Captured after pupil dilation — 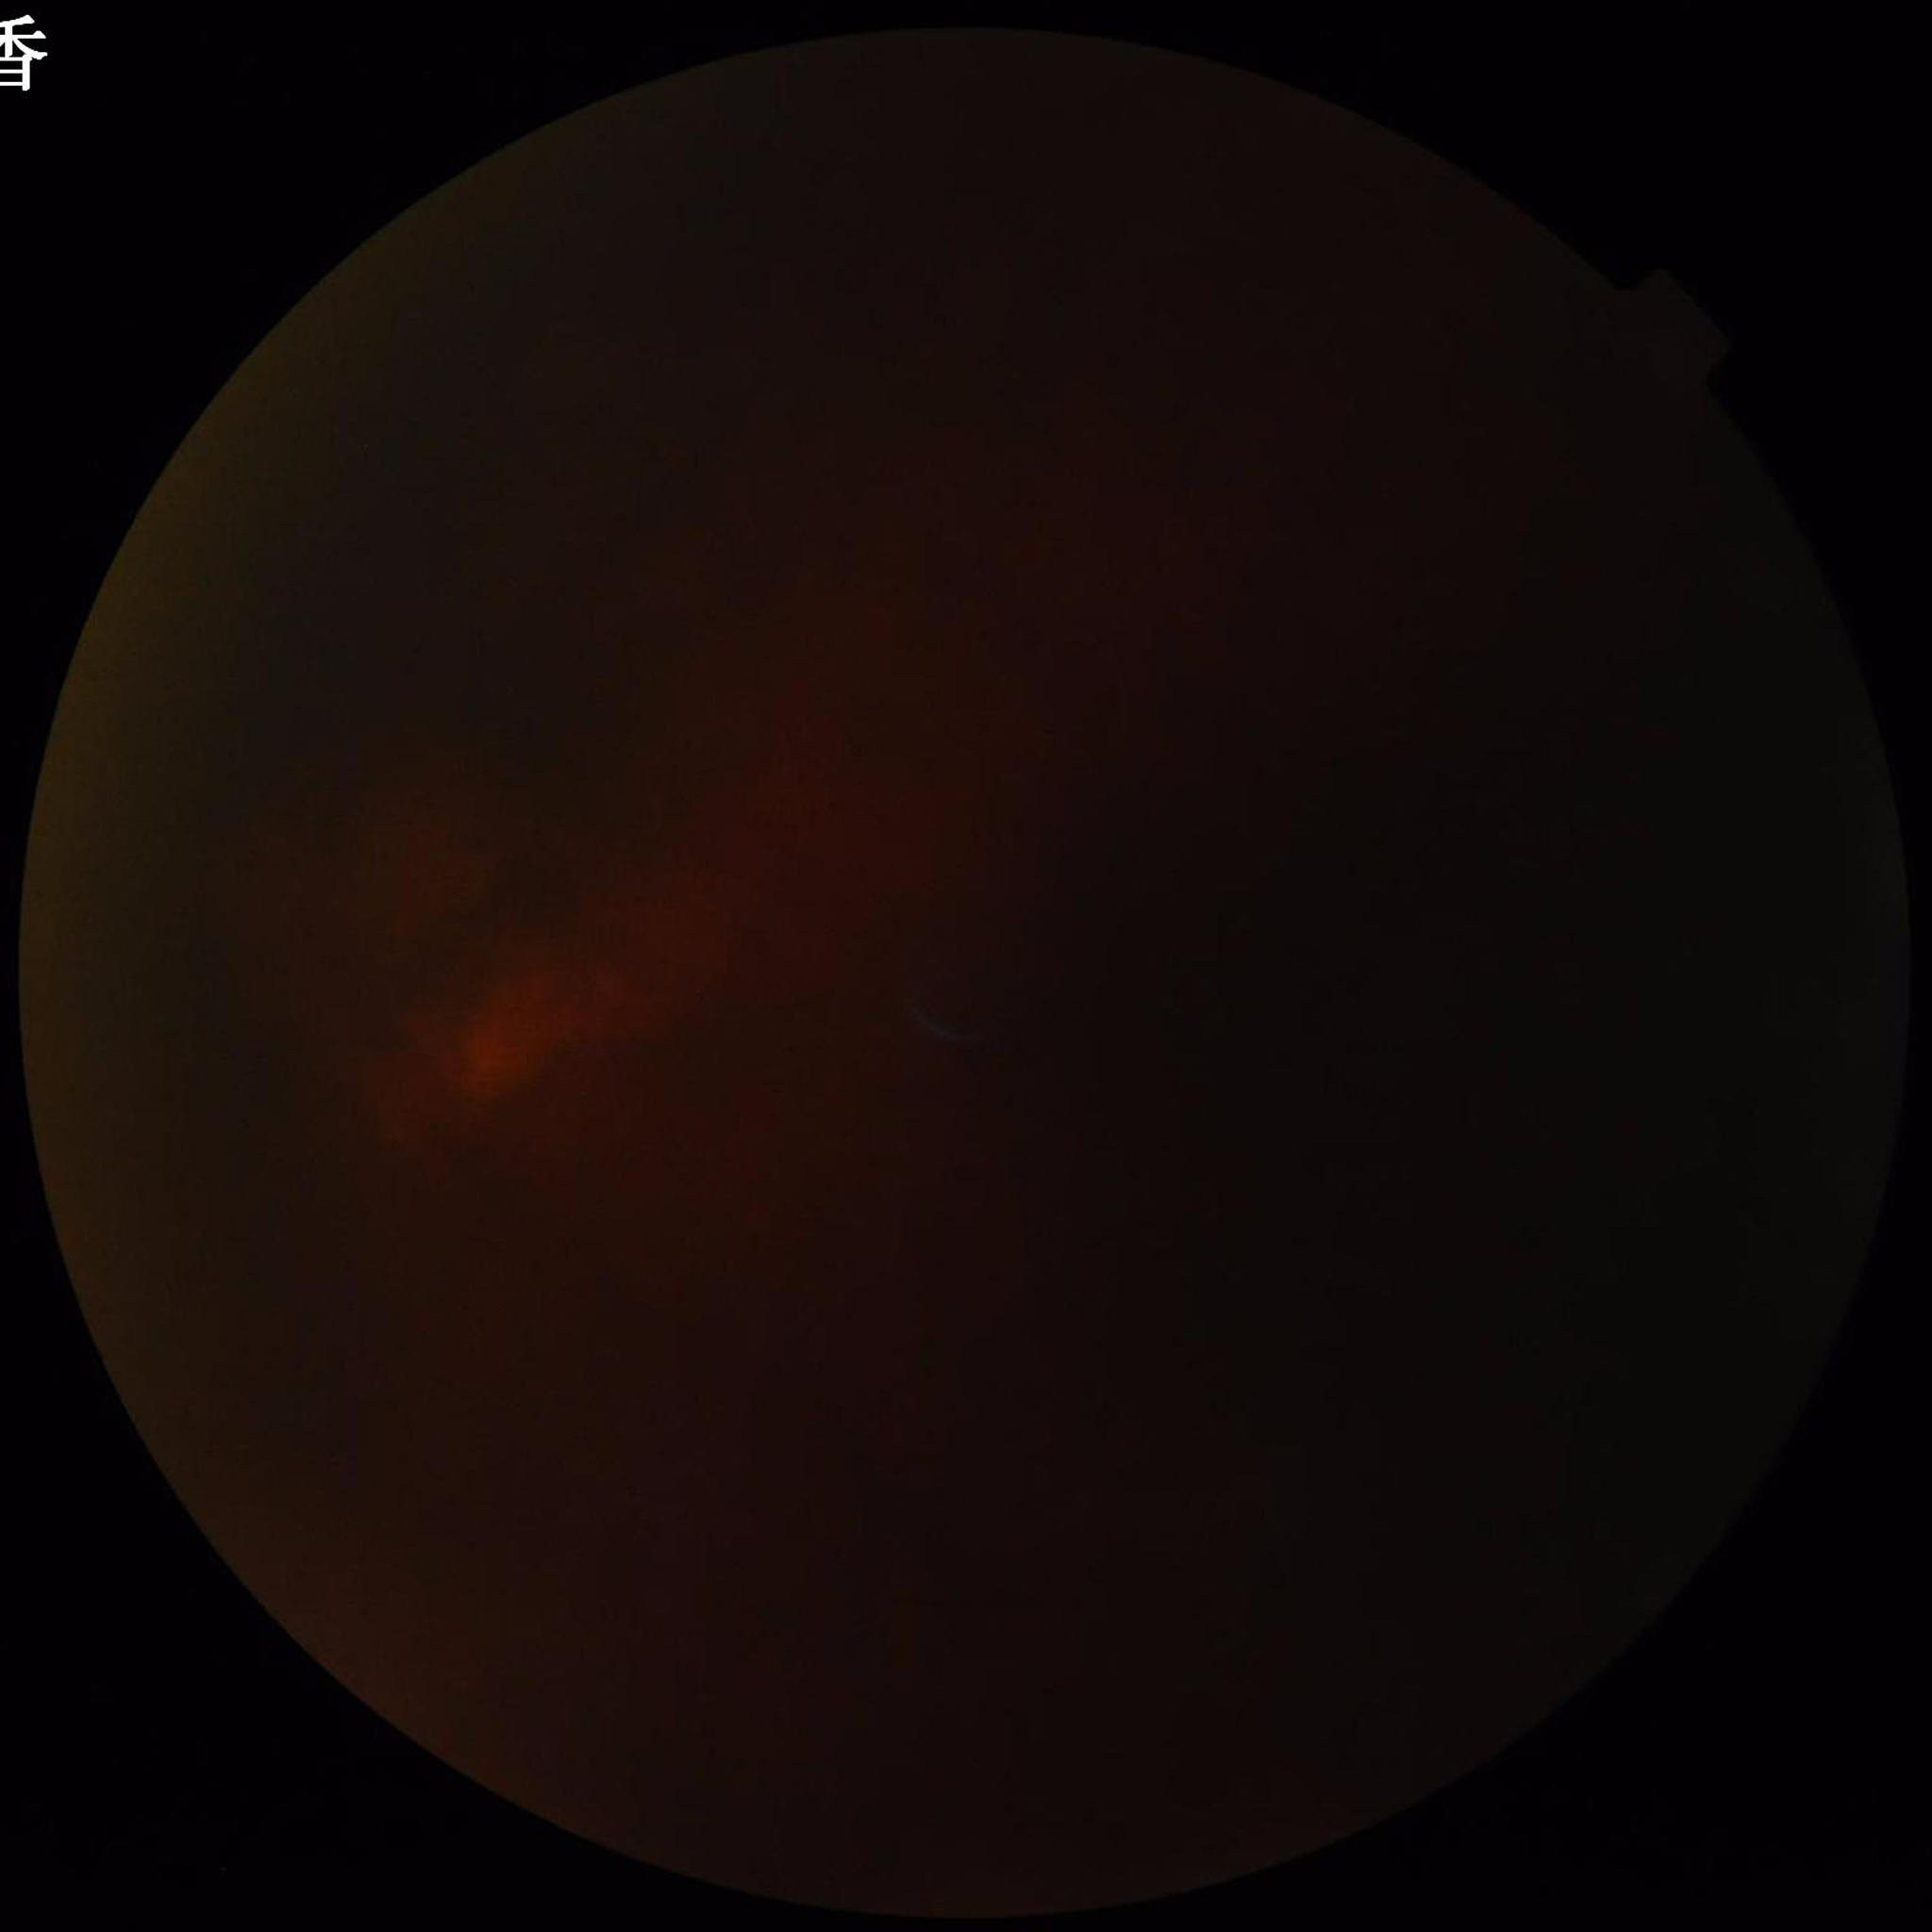

Diagnosis: glaucoma.